Wide-field fundus photograph from neonatal ROP screening: 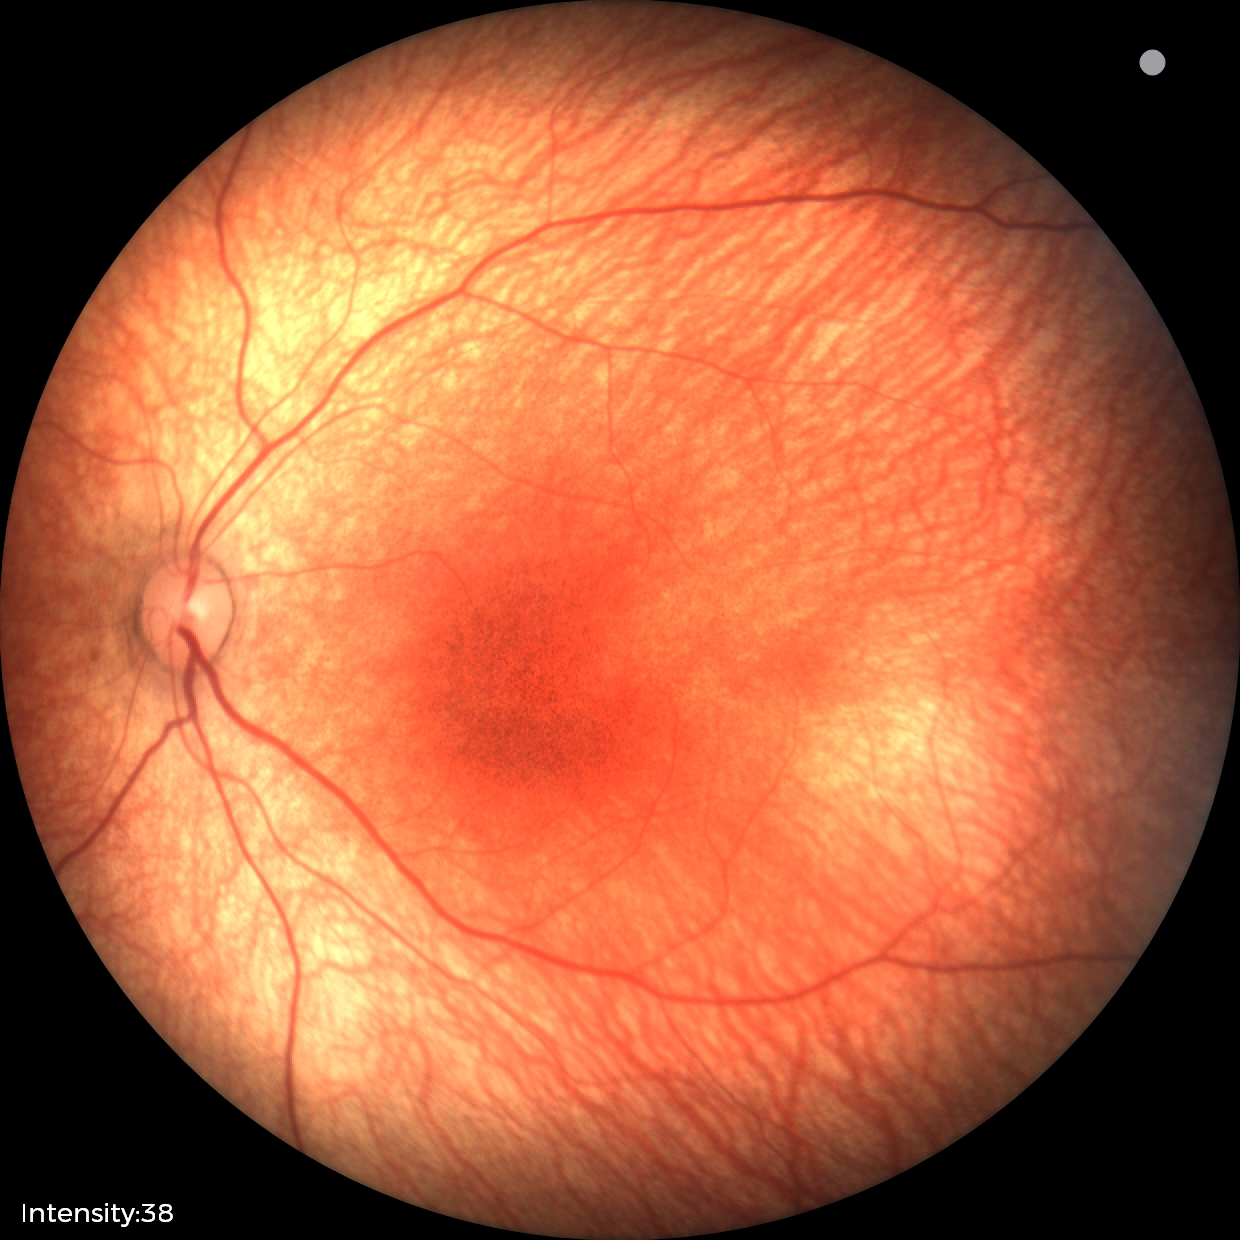
Diagnosis = normal